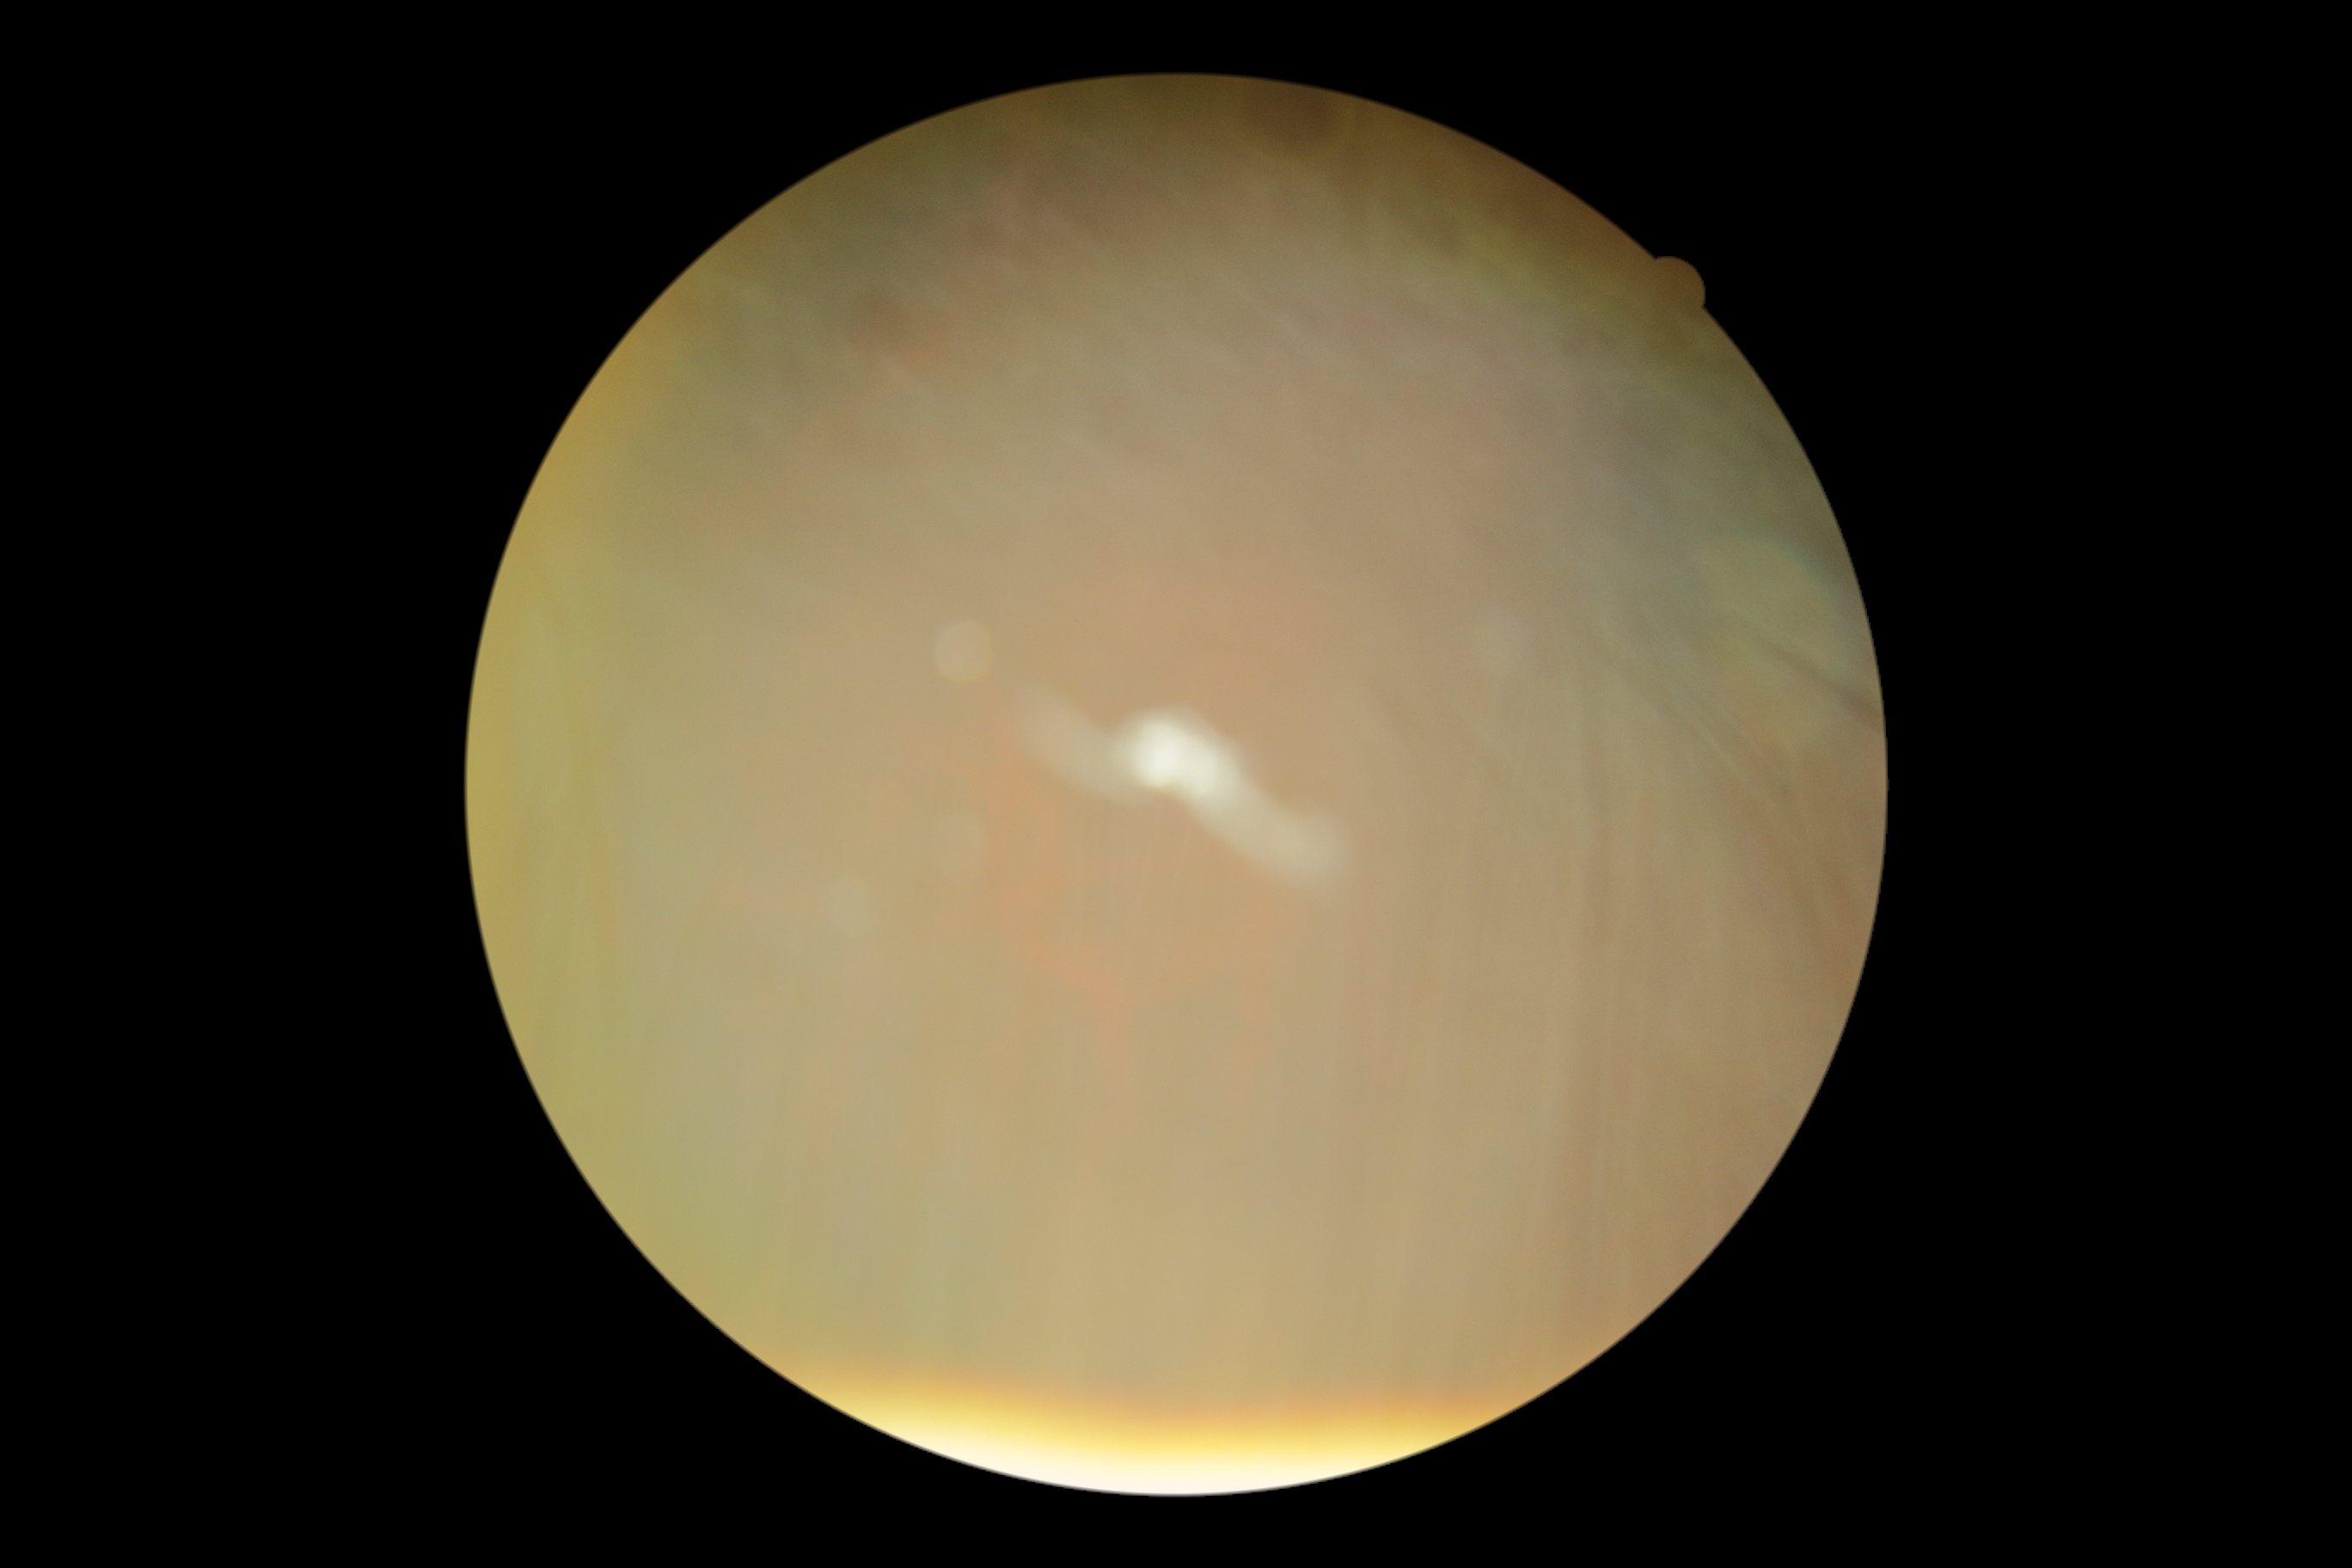 DR severity: ungradable.
Quality too poor to assess for DR.